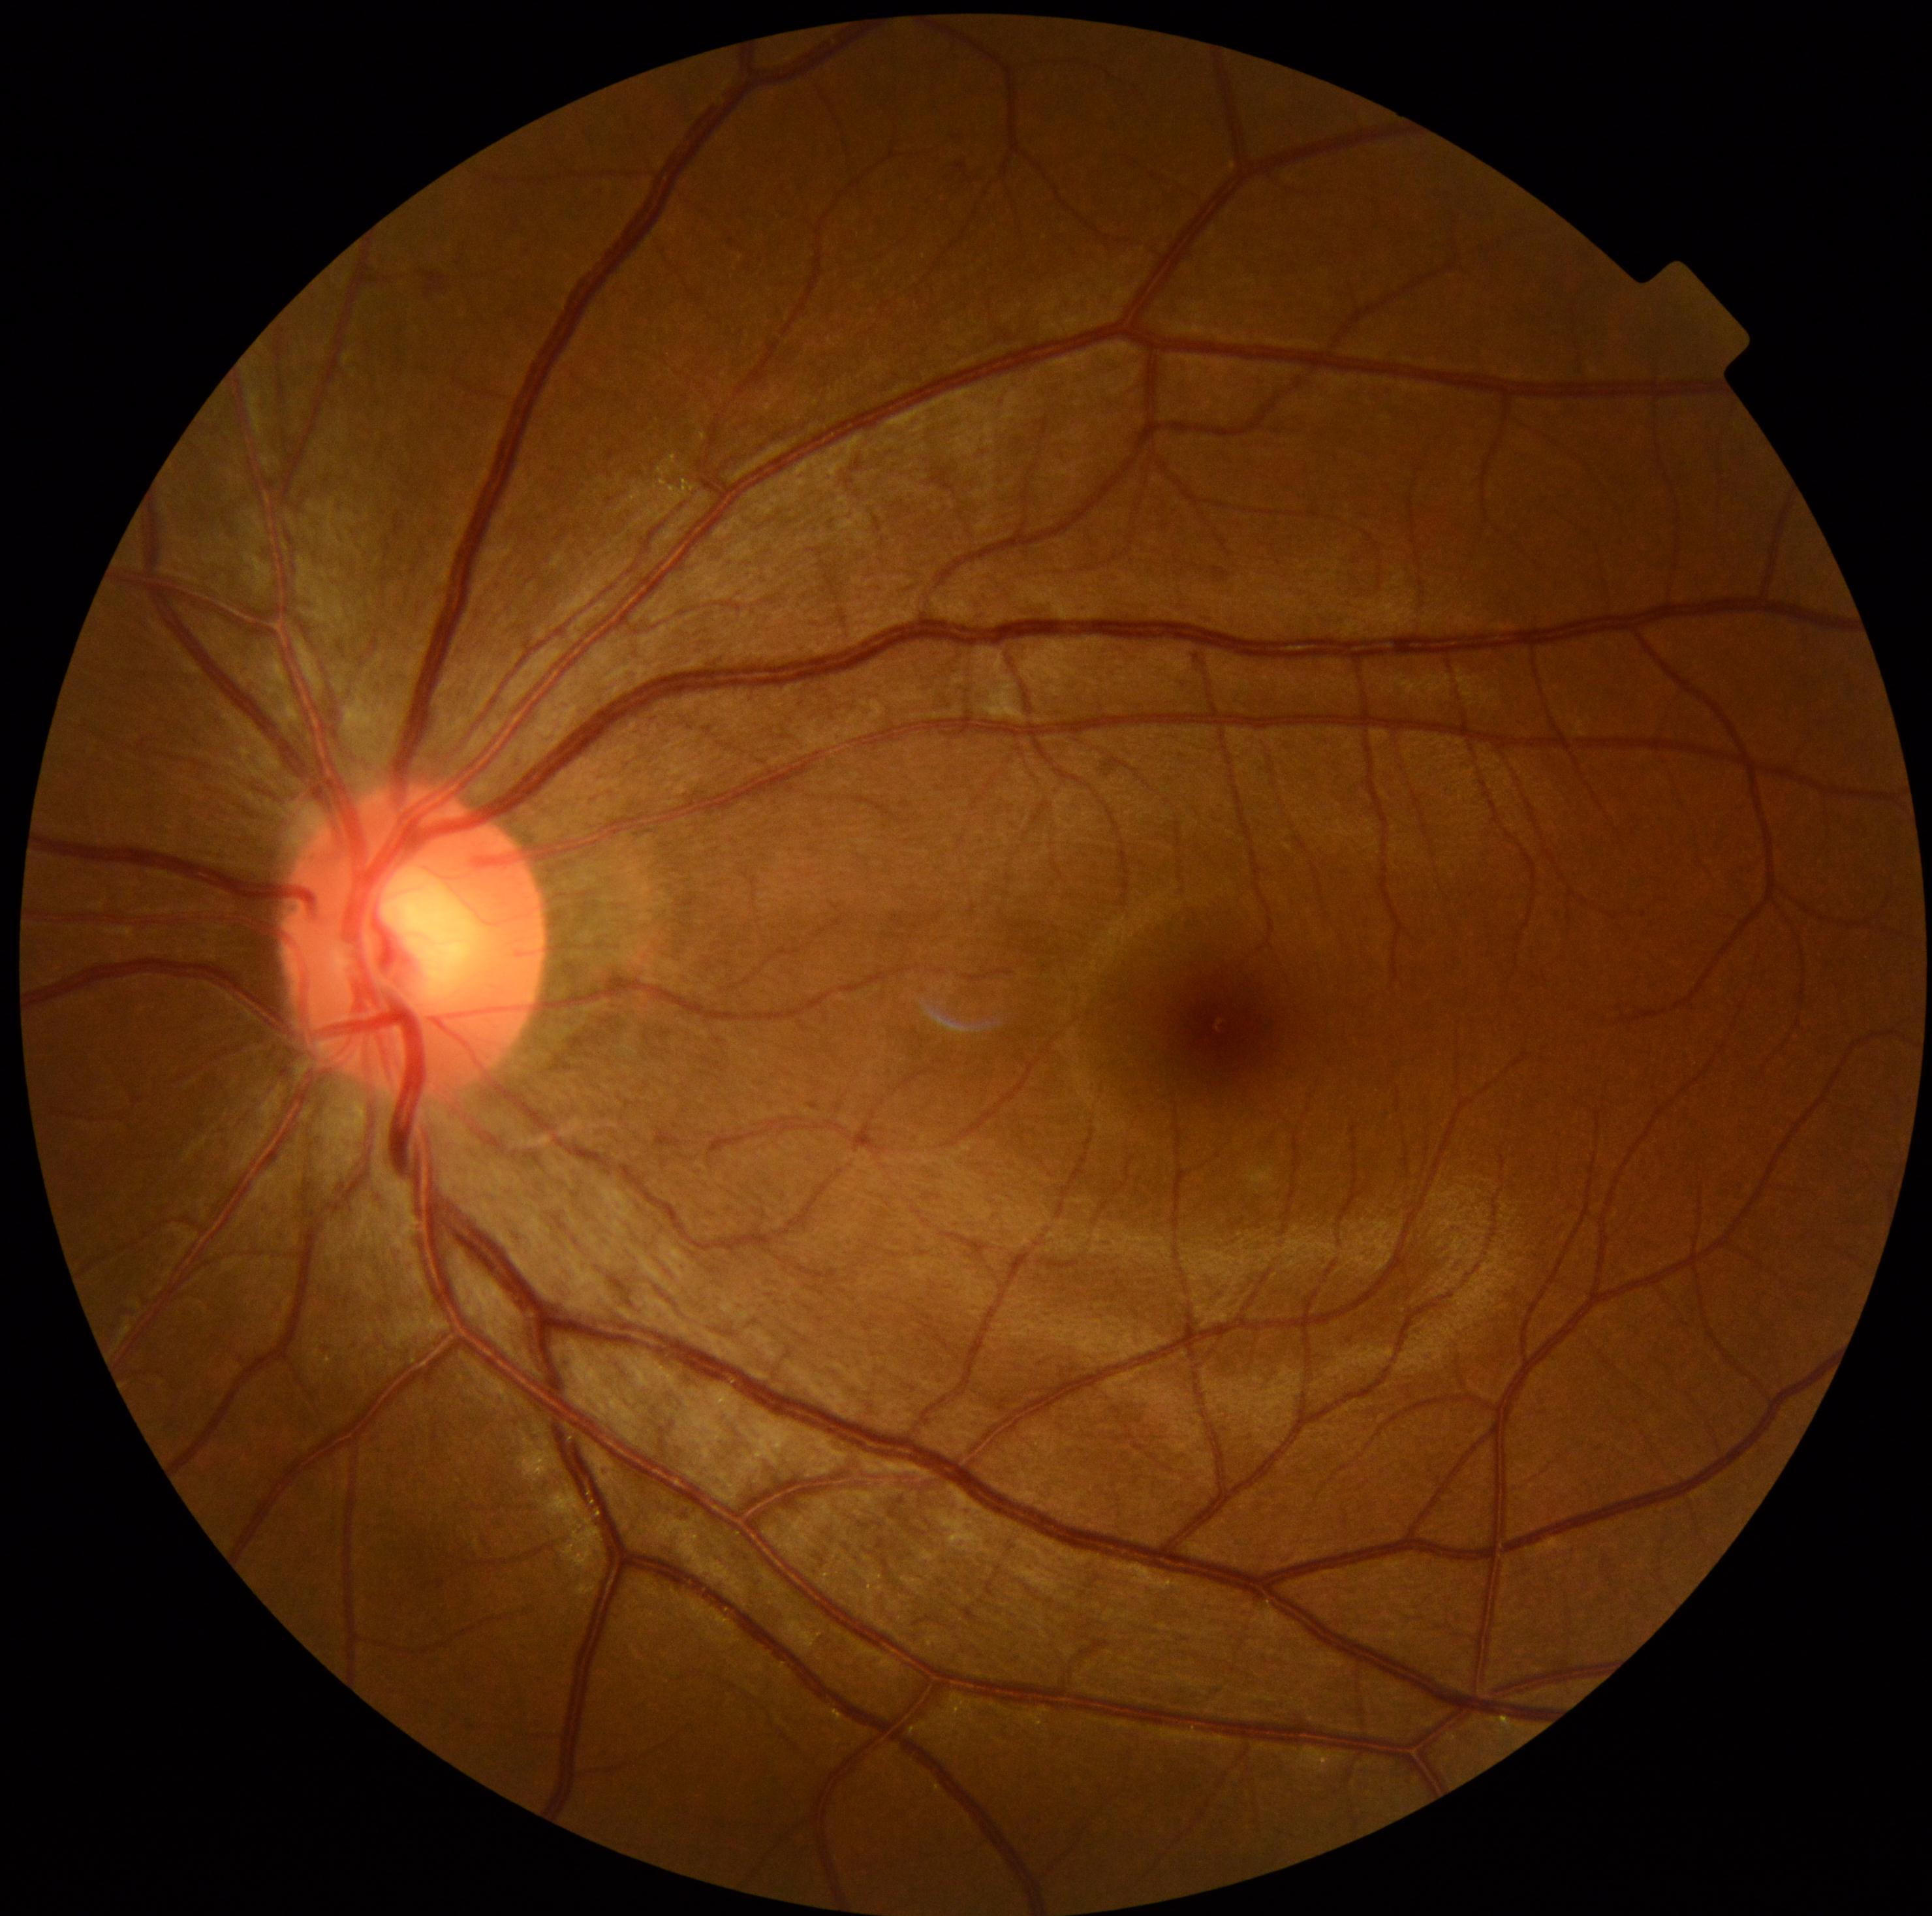
diabetic retinopathy (DR)=no apparent diabetic retinopathy (grade 0).